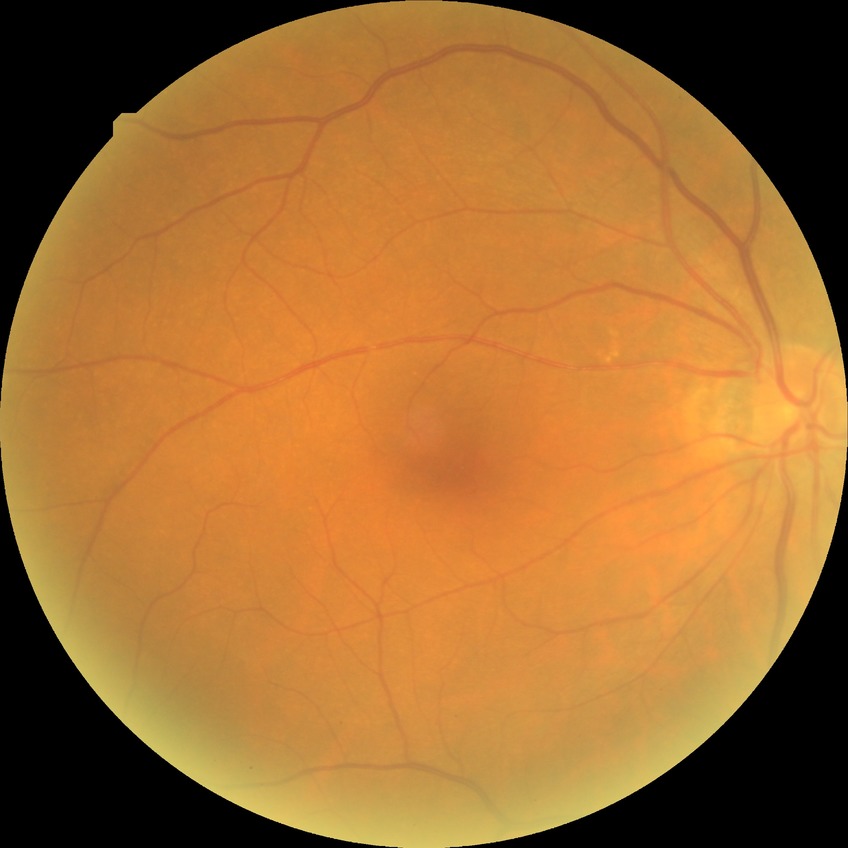
diabetic retinopathy (DR): NDR (no diabetic retinopathy)